FOV: 45 degrees, acquired with a NIDEK AFC-230, 848 x 848 pixels, without pupil dilation: 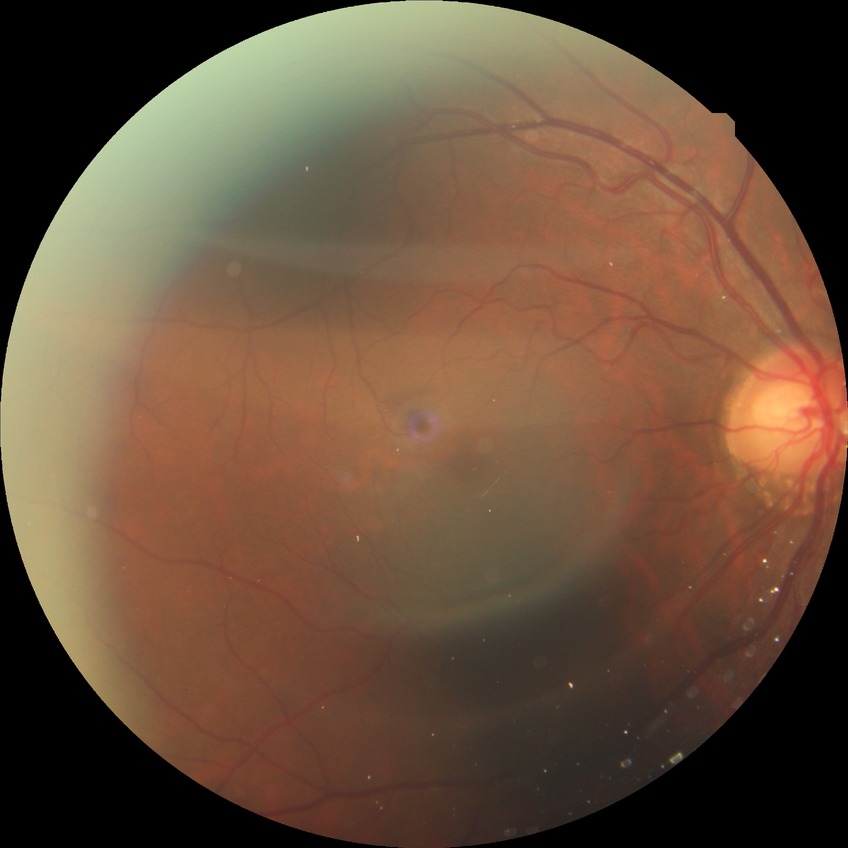

{
  "davis_grade": "NDR",
  "dr_impression": "no signs of DR"
}